512 x 512 pixels:
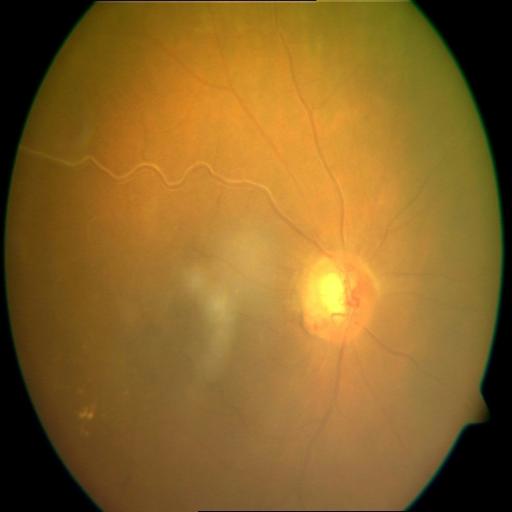

Diagnosis: cystoid macular edema (CME); vasculitis (VS).